DR severity per modified Davis staging · acquired with a NIDEK AFC-230 — 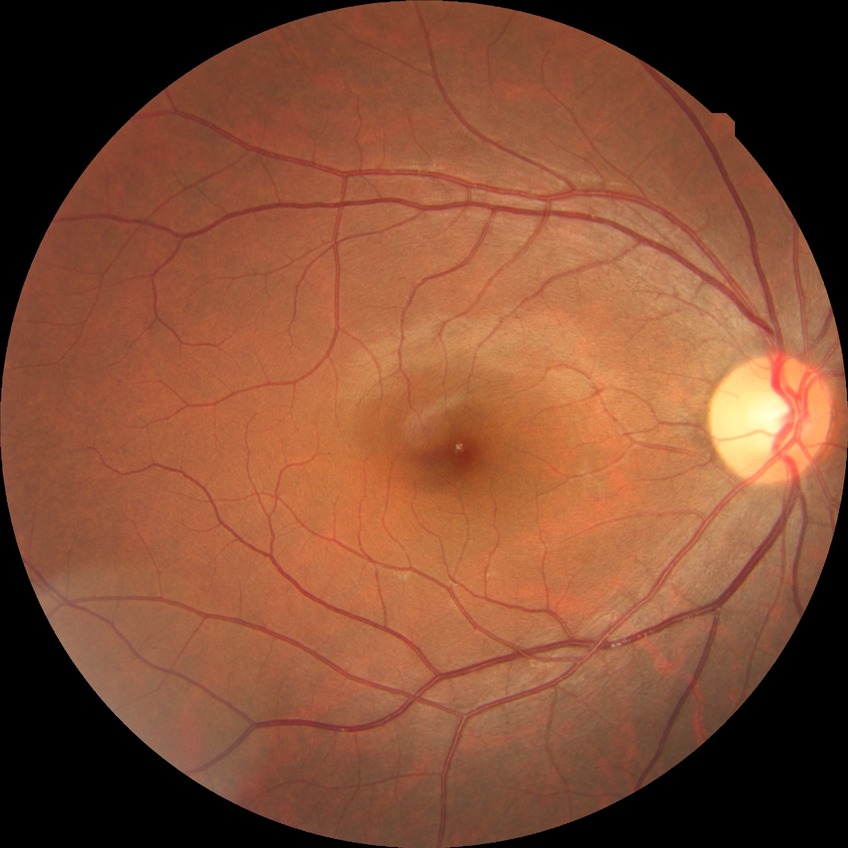

Diabetic retinopathy stage: no diabetic retinopathy.